NIDEK AFC-230 fundus camera; diabetic retinopathy graded by the modified Davis classification.
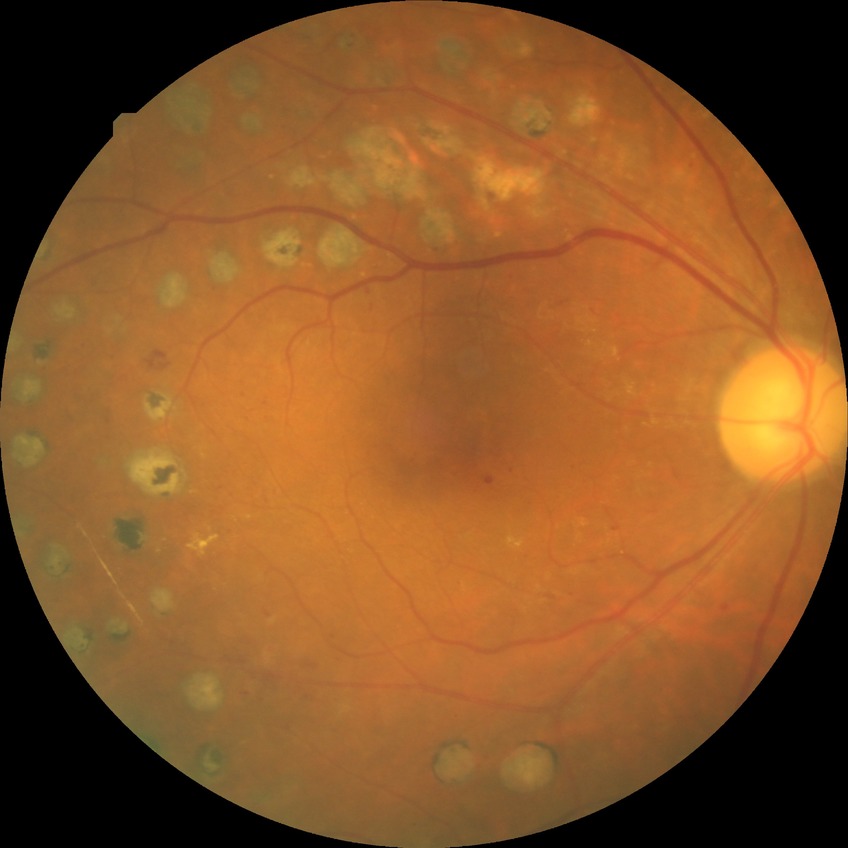
Diabetic retinopathy (DR): PDR (proliferative diabetic retinopathy).